NIDEK AFC-230. Image size 848x848 — 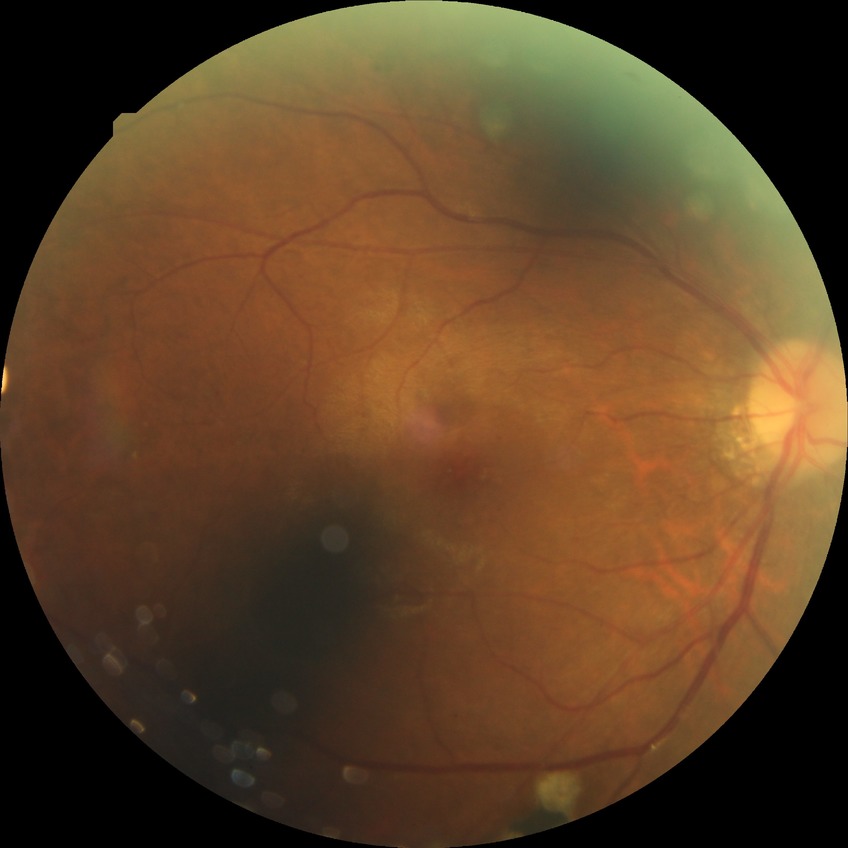

Diabetic retinopathy (DR): PDR (proliferative diabetic retinopathy).